Image size 1440x1080; wide-field fundus photograph of an infant
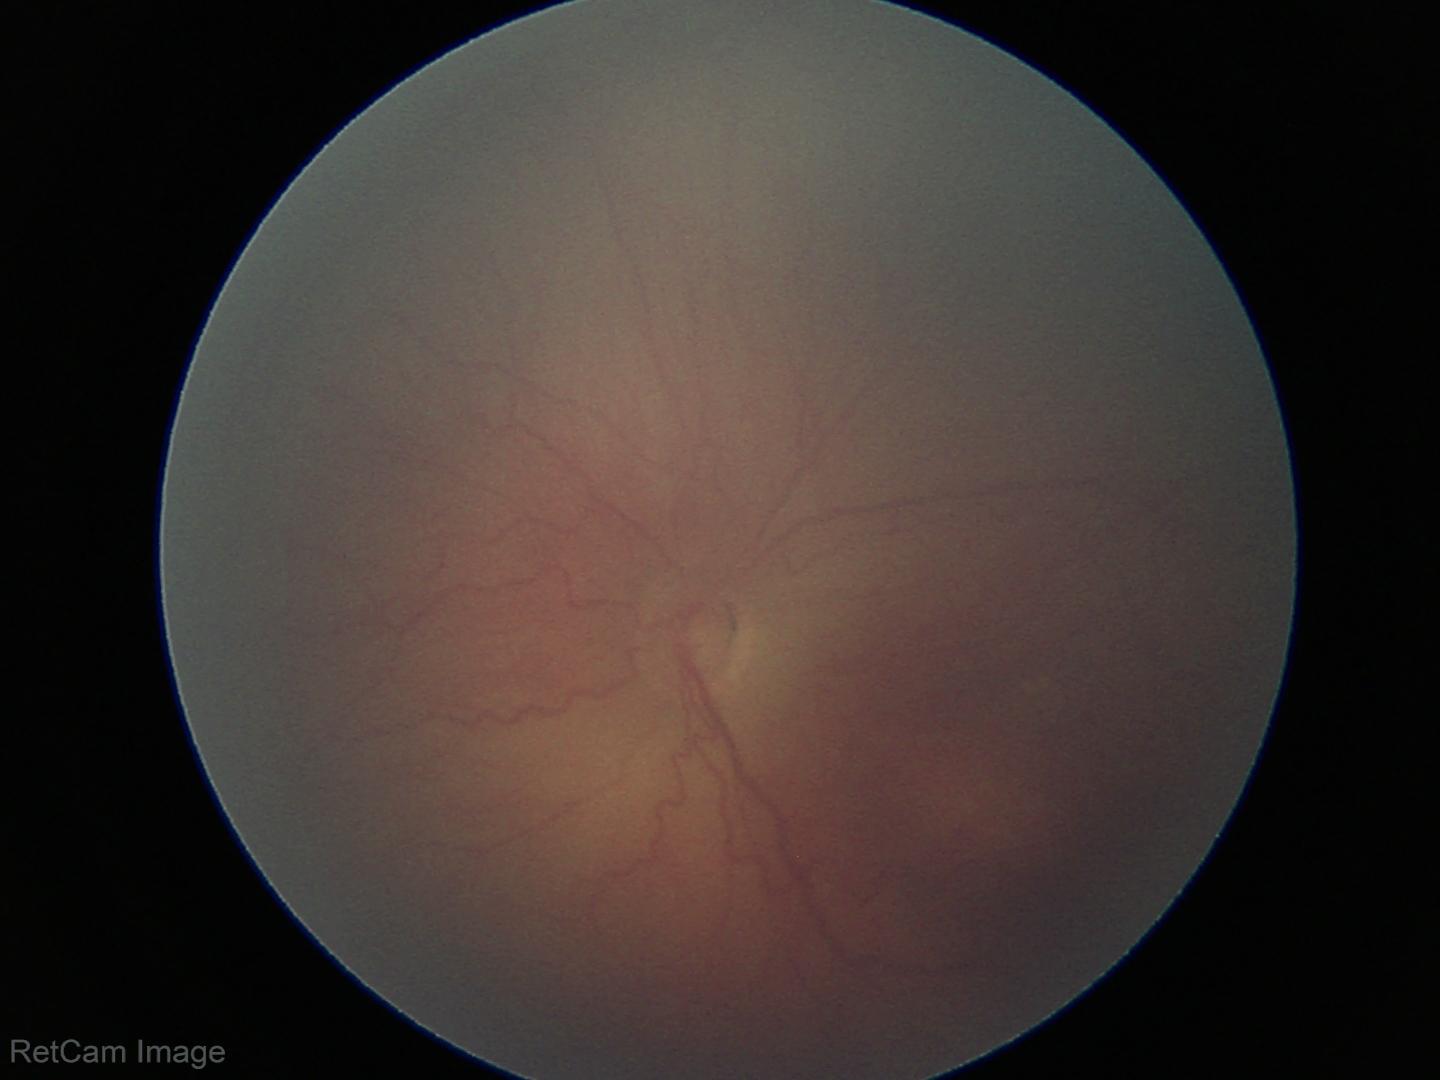 Plus disease = absent | diagnosis = ROP stage 2.